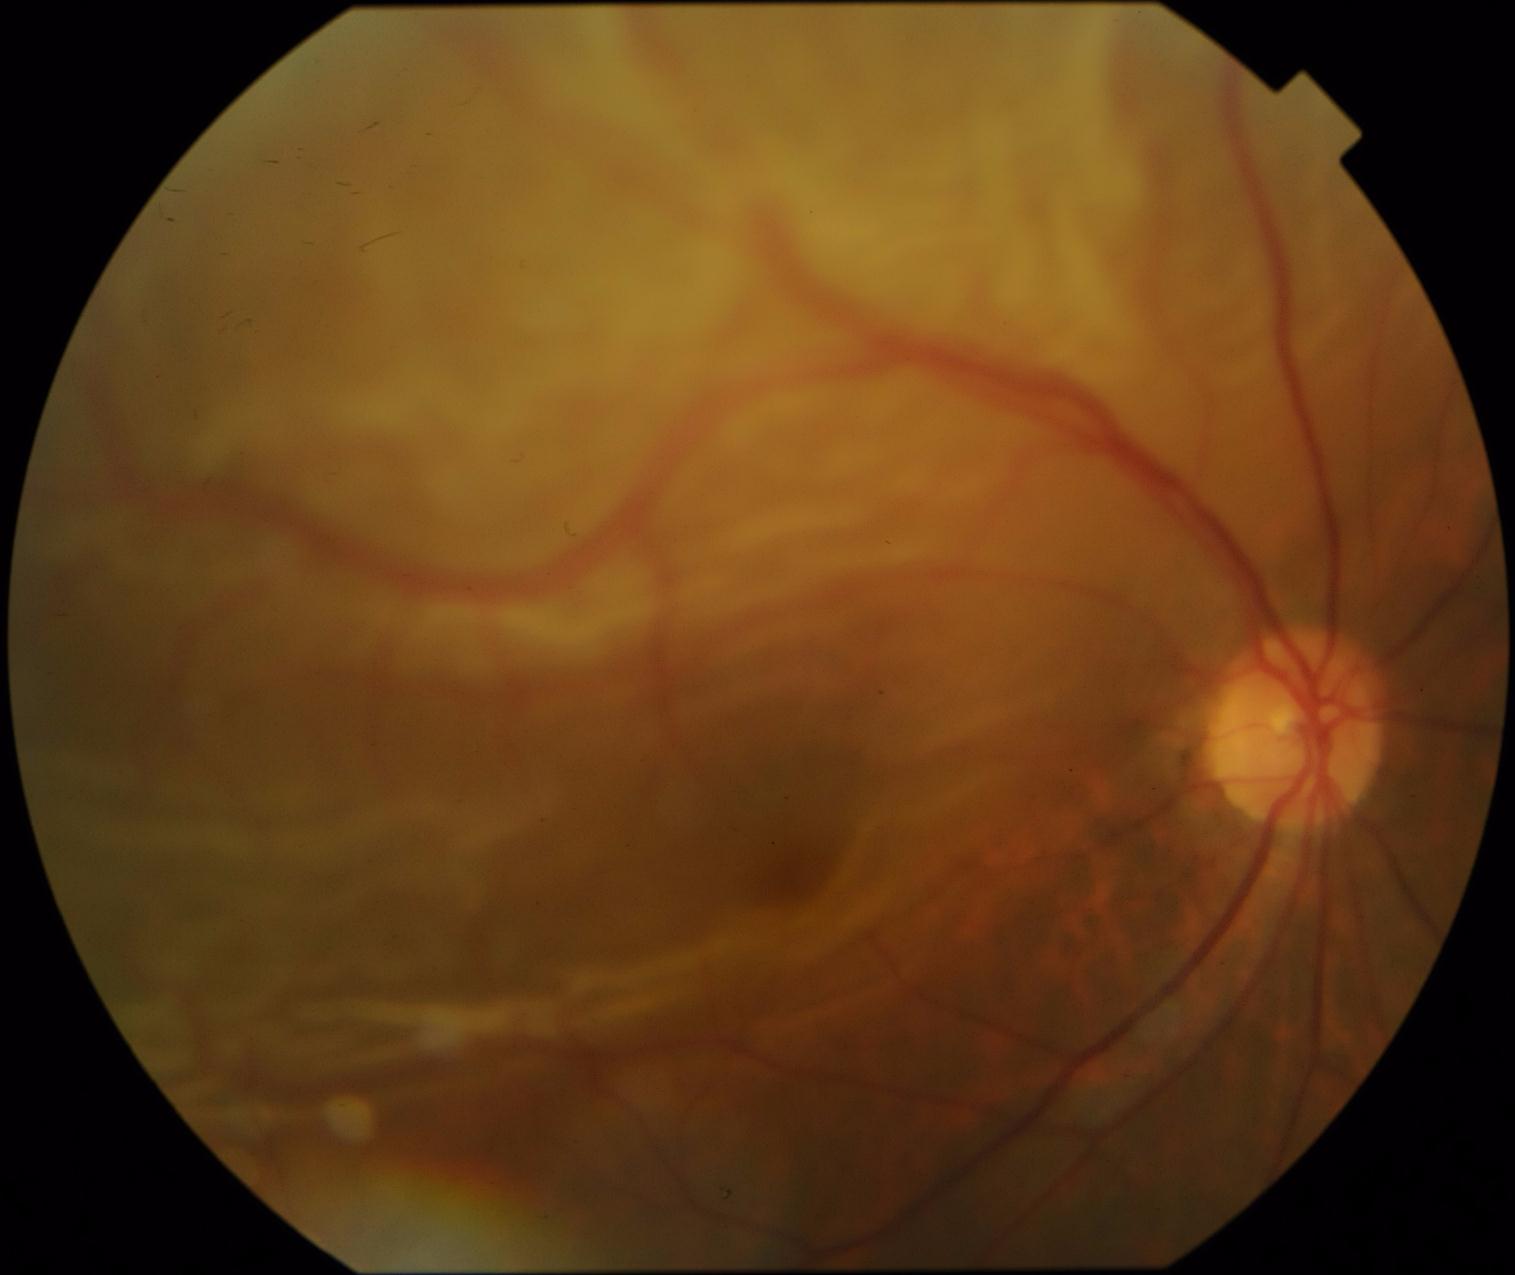

• diabetic retinopathy severity — grade 4 (PDR)
• DR class — proliferative diabetic retinopathy